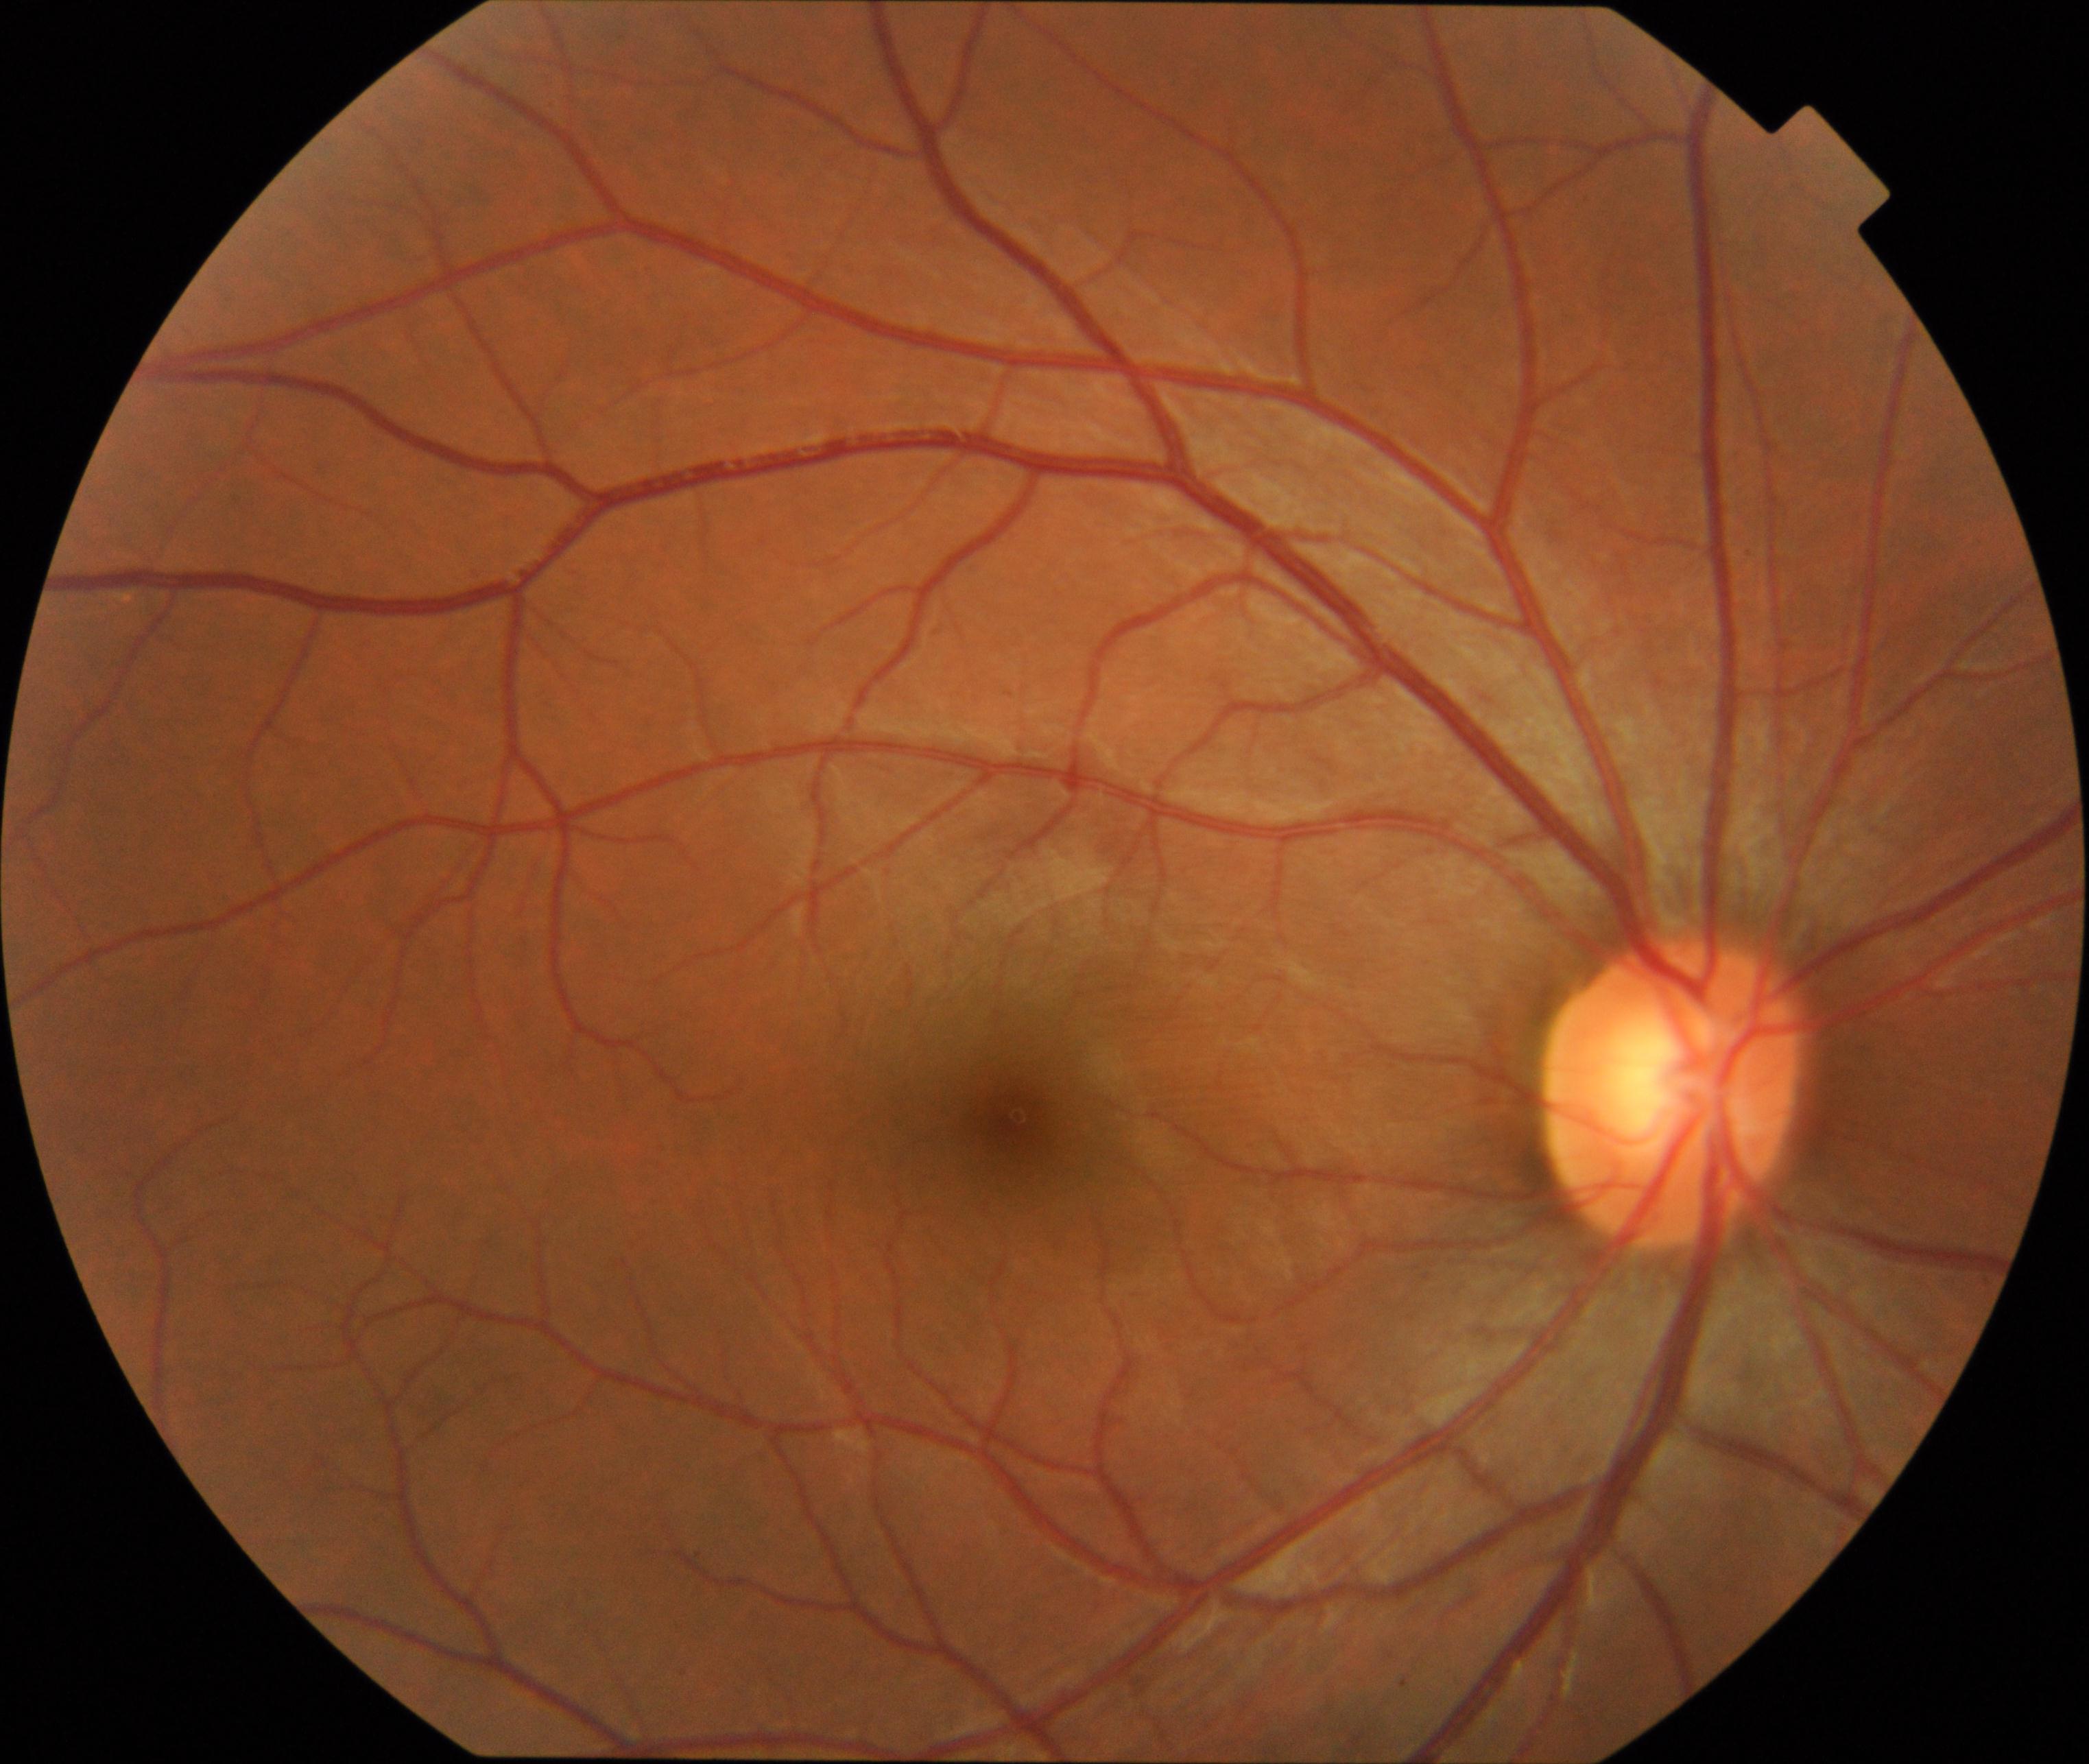 Findings: no abnormalities.